CFP, 45° FOV, 1932 x 1916 pixels.
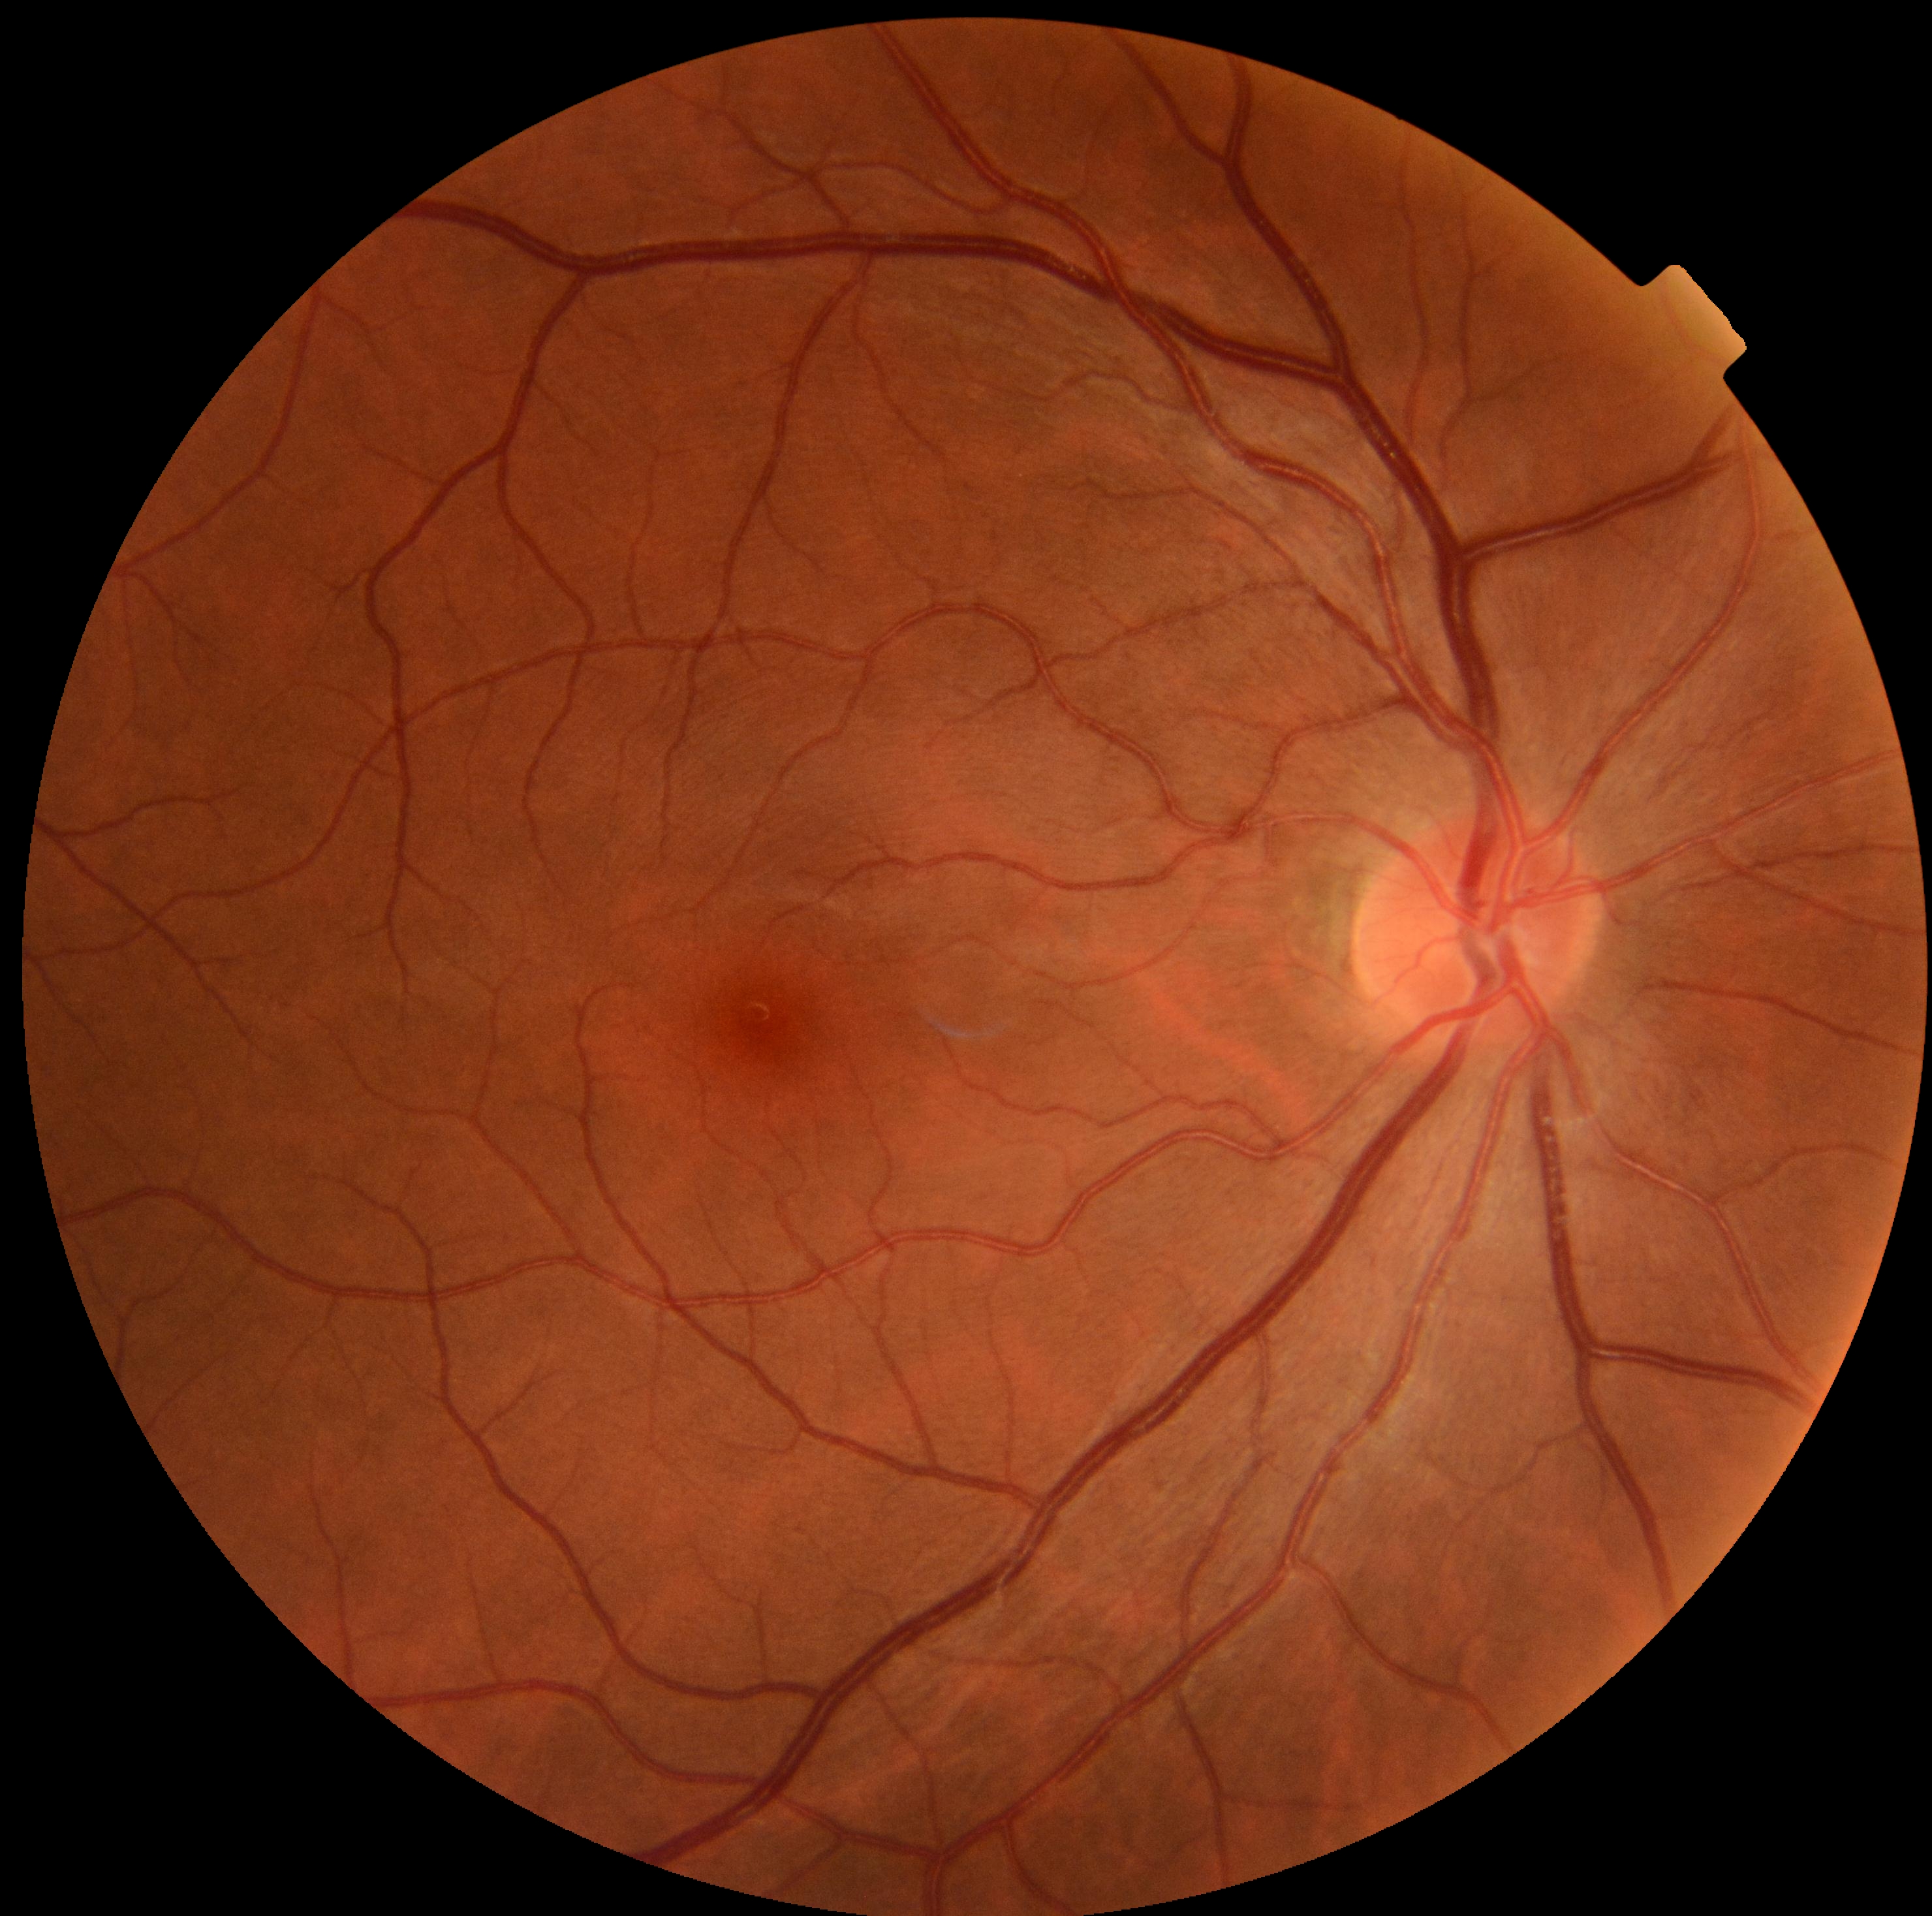 diabetic retinopathy = grade 0 (no apparent retinopathy) — no visible signs of diabetic retinopathy.